45° field of view; 2352 x 1568 pixels; color fundus image: 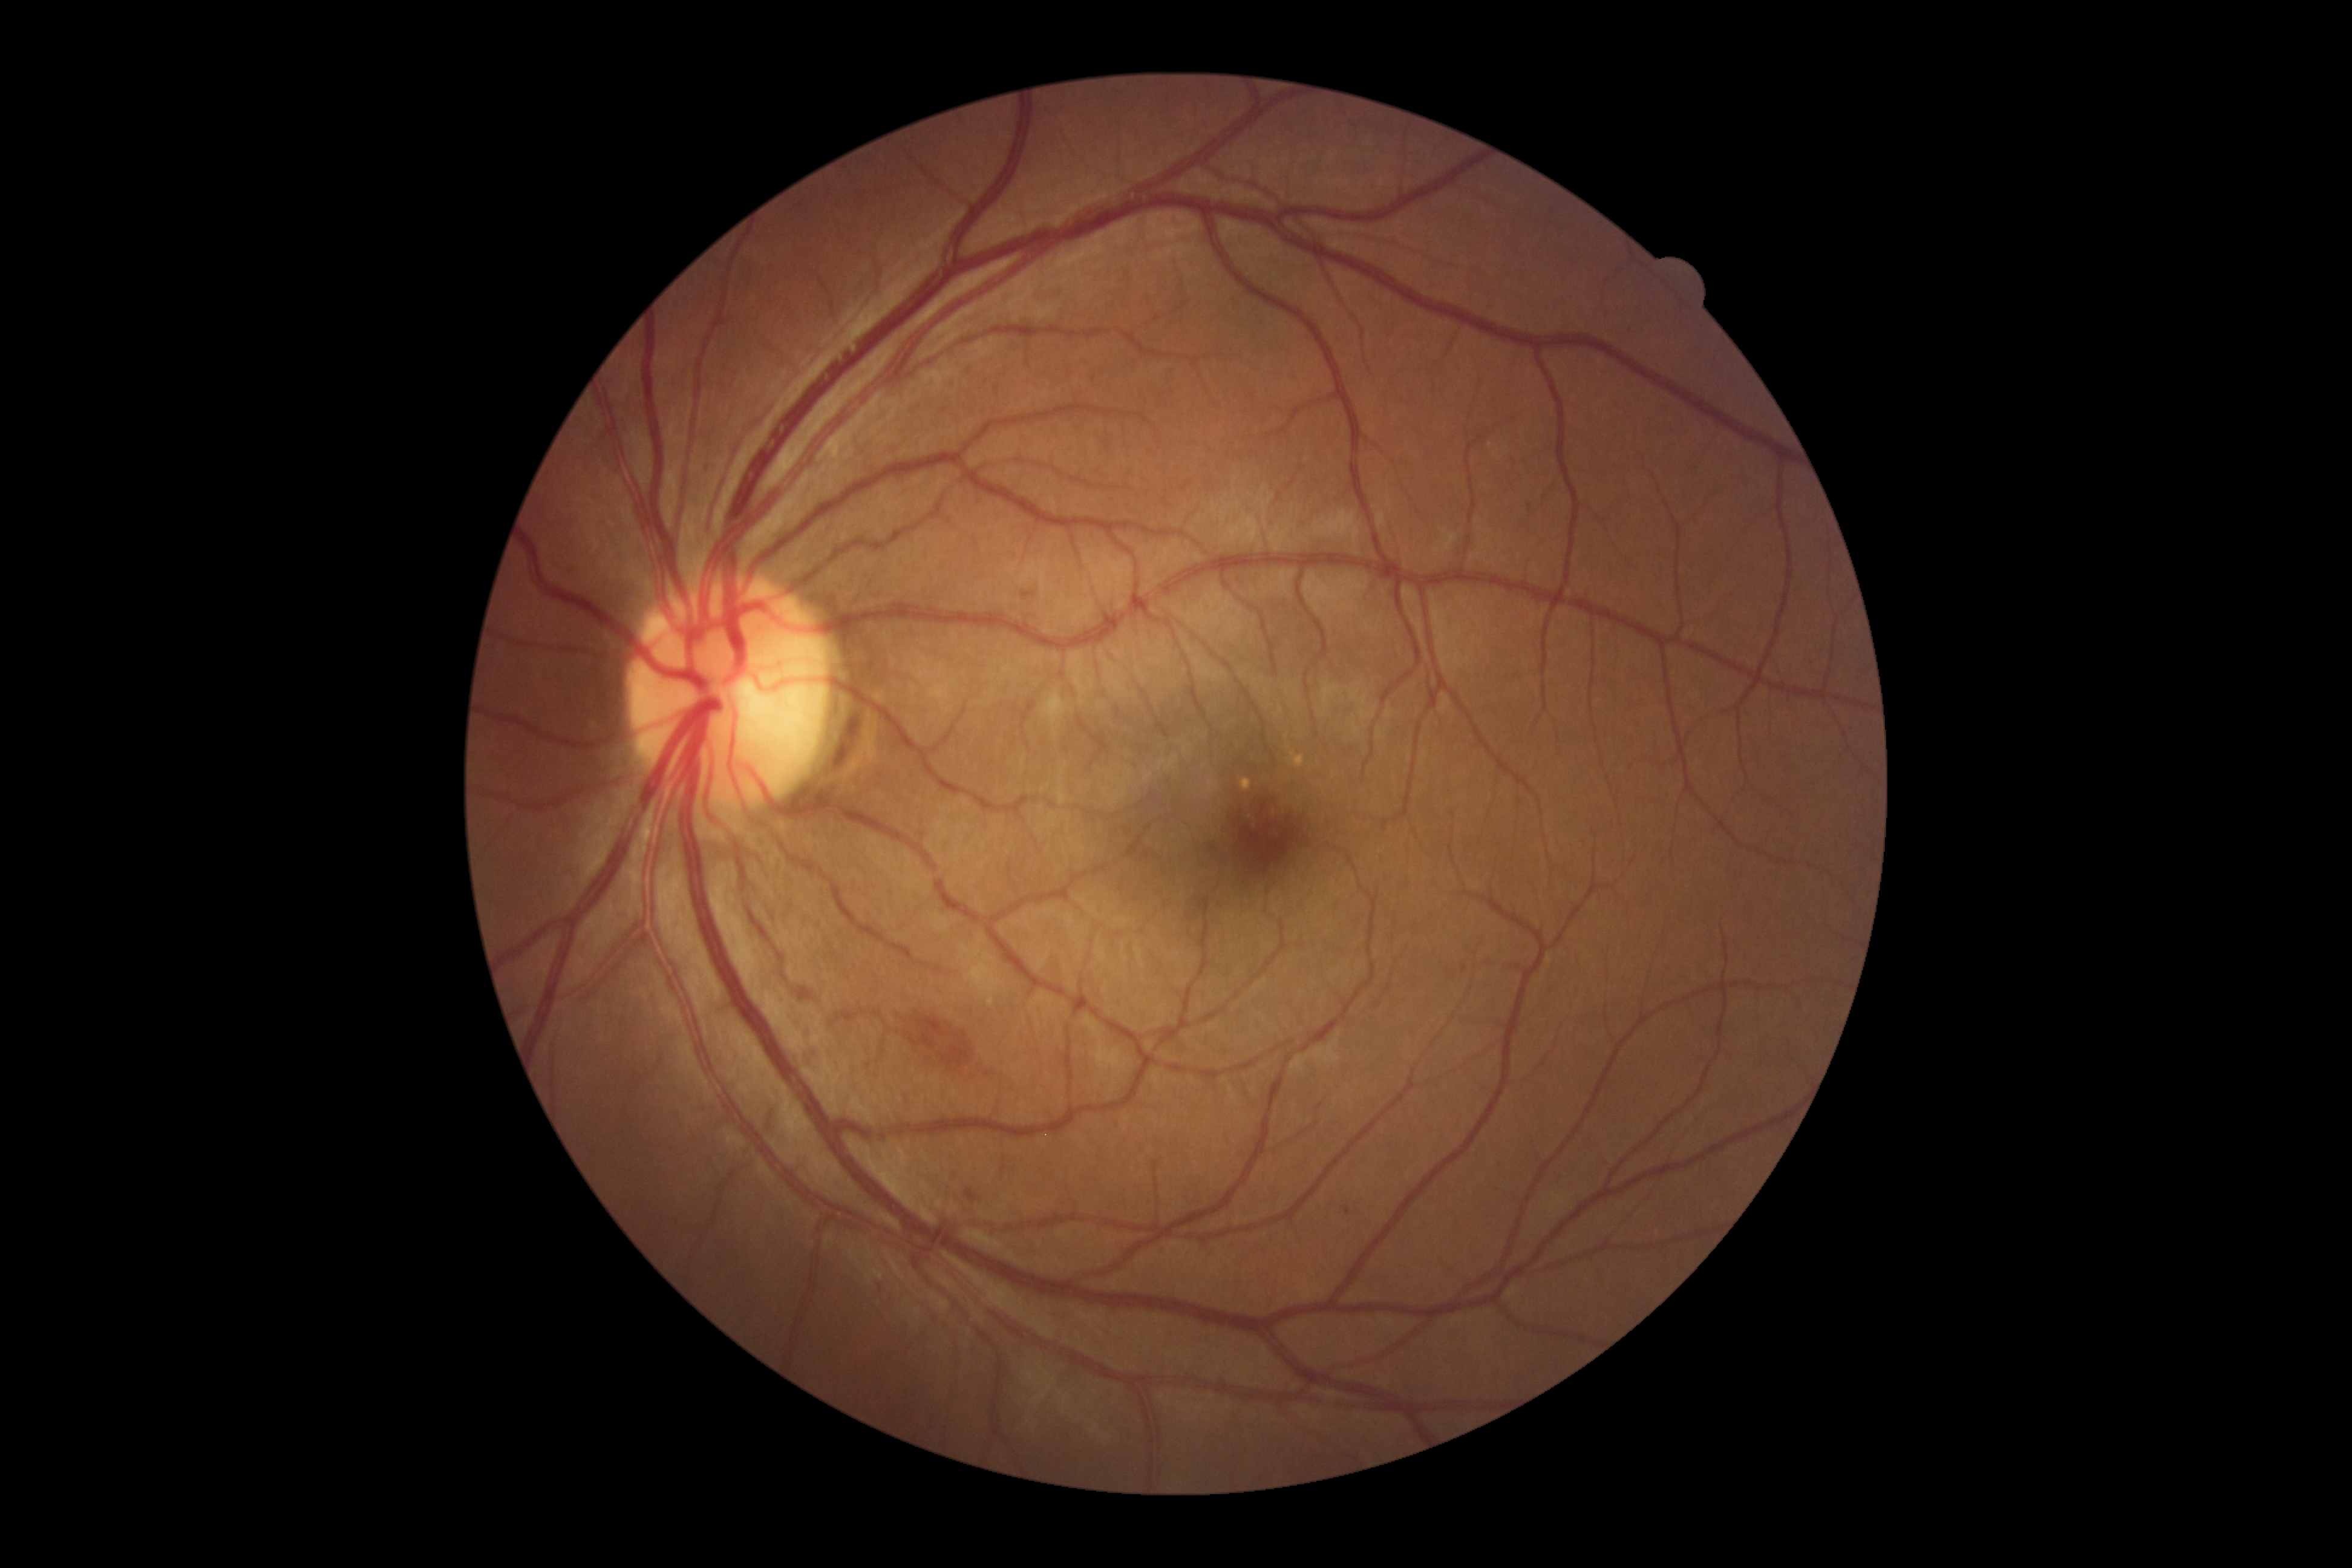

dr_grade: 2
dr_grade_name: moderate NPDR
lesions:
  he:
    - {"left": 828, "top": 1007, "right": 884, "bottom": 1028}
    - {"left": 889, "top": 1006, "right": 1010, "bottom": 1086}
  se: []
  ex: []
  ma:
    - {"left": 878, "top": 1281, "right": 884, "bottom": 1293}
    - {"left": 1345, "top": 1206, "right": 1351, "bottom": 1215}
    - {"left": 965, "top": 1189, "right": 979, "bottom": 1201}
    - {"left": 1462, "top": 961, "right": 1467, "bottom": 972}
    - {"left": 1022, "top": 592, "right": 1031, "bottom": 597}
    - {"left": 1527, "top": 504, "right": 1532, "bottom": 512}